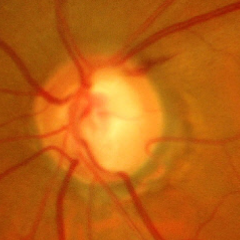

Findings consistent with glaucoma. Fundus image with findings of advanced glaucoma.